Without pupil dilation. Diabetic retinopathy graded by the modified Davis classification
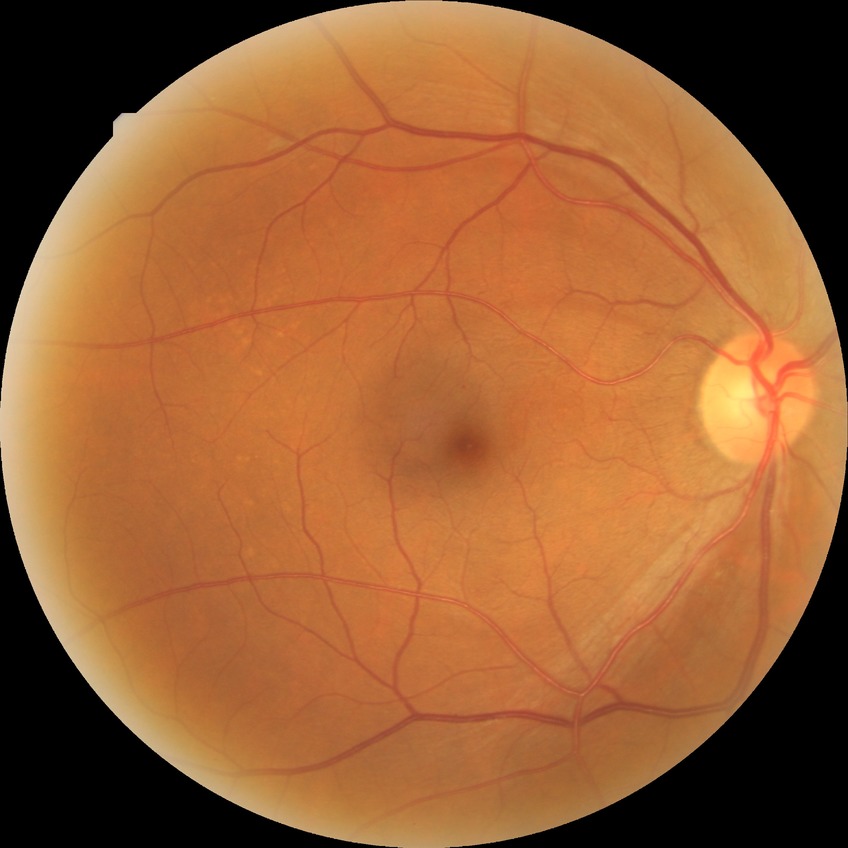 diabetic retinopathy stage = no diabetic retinopathy.